45° FOV, color fundus image
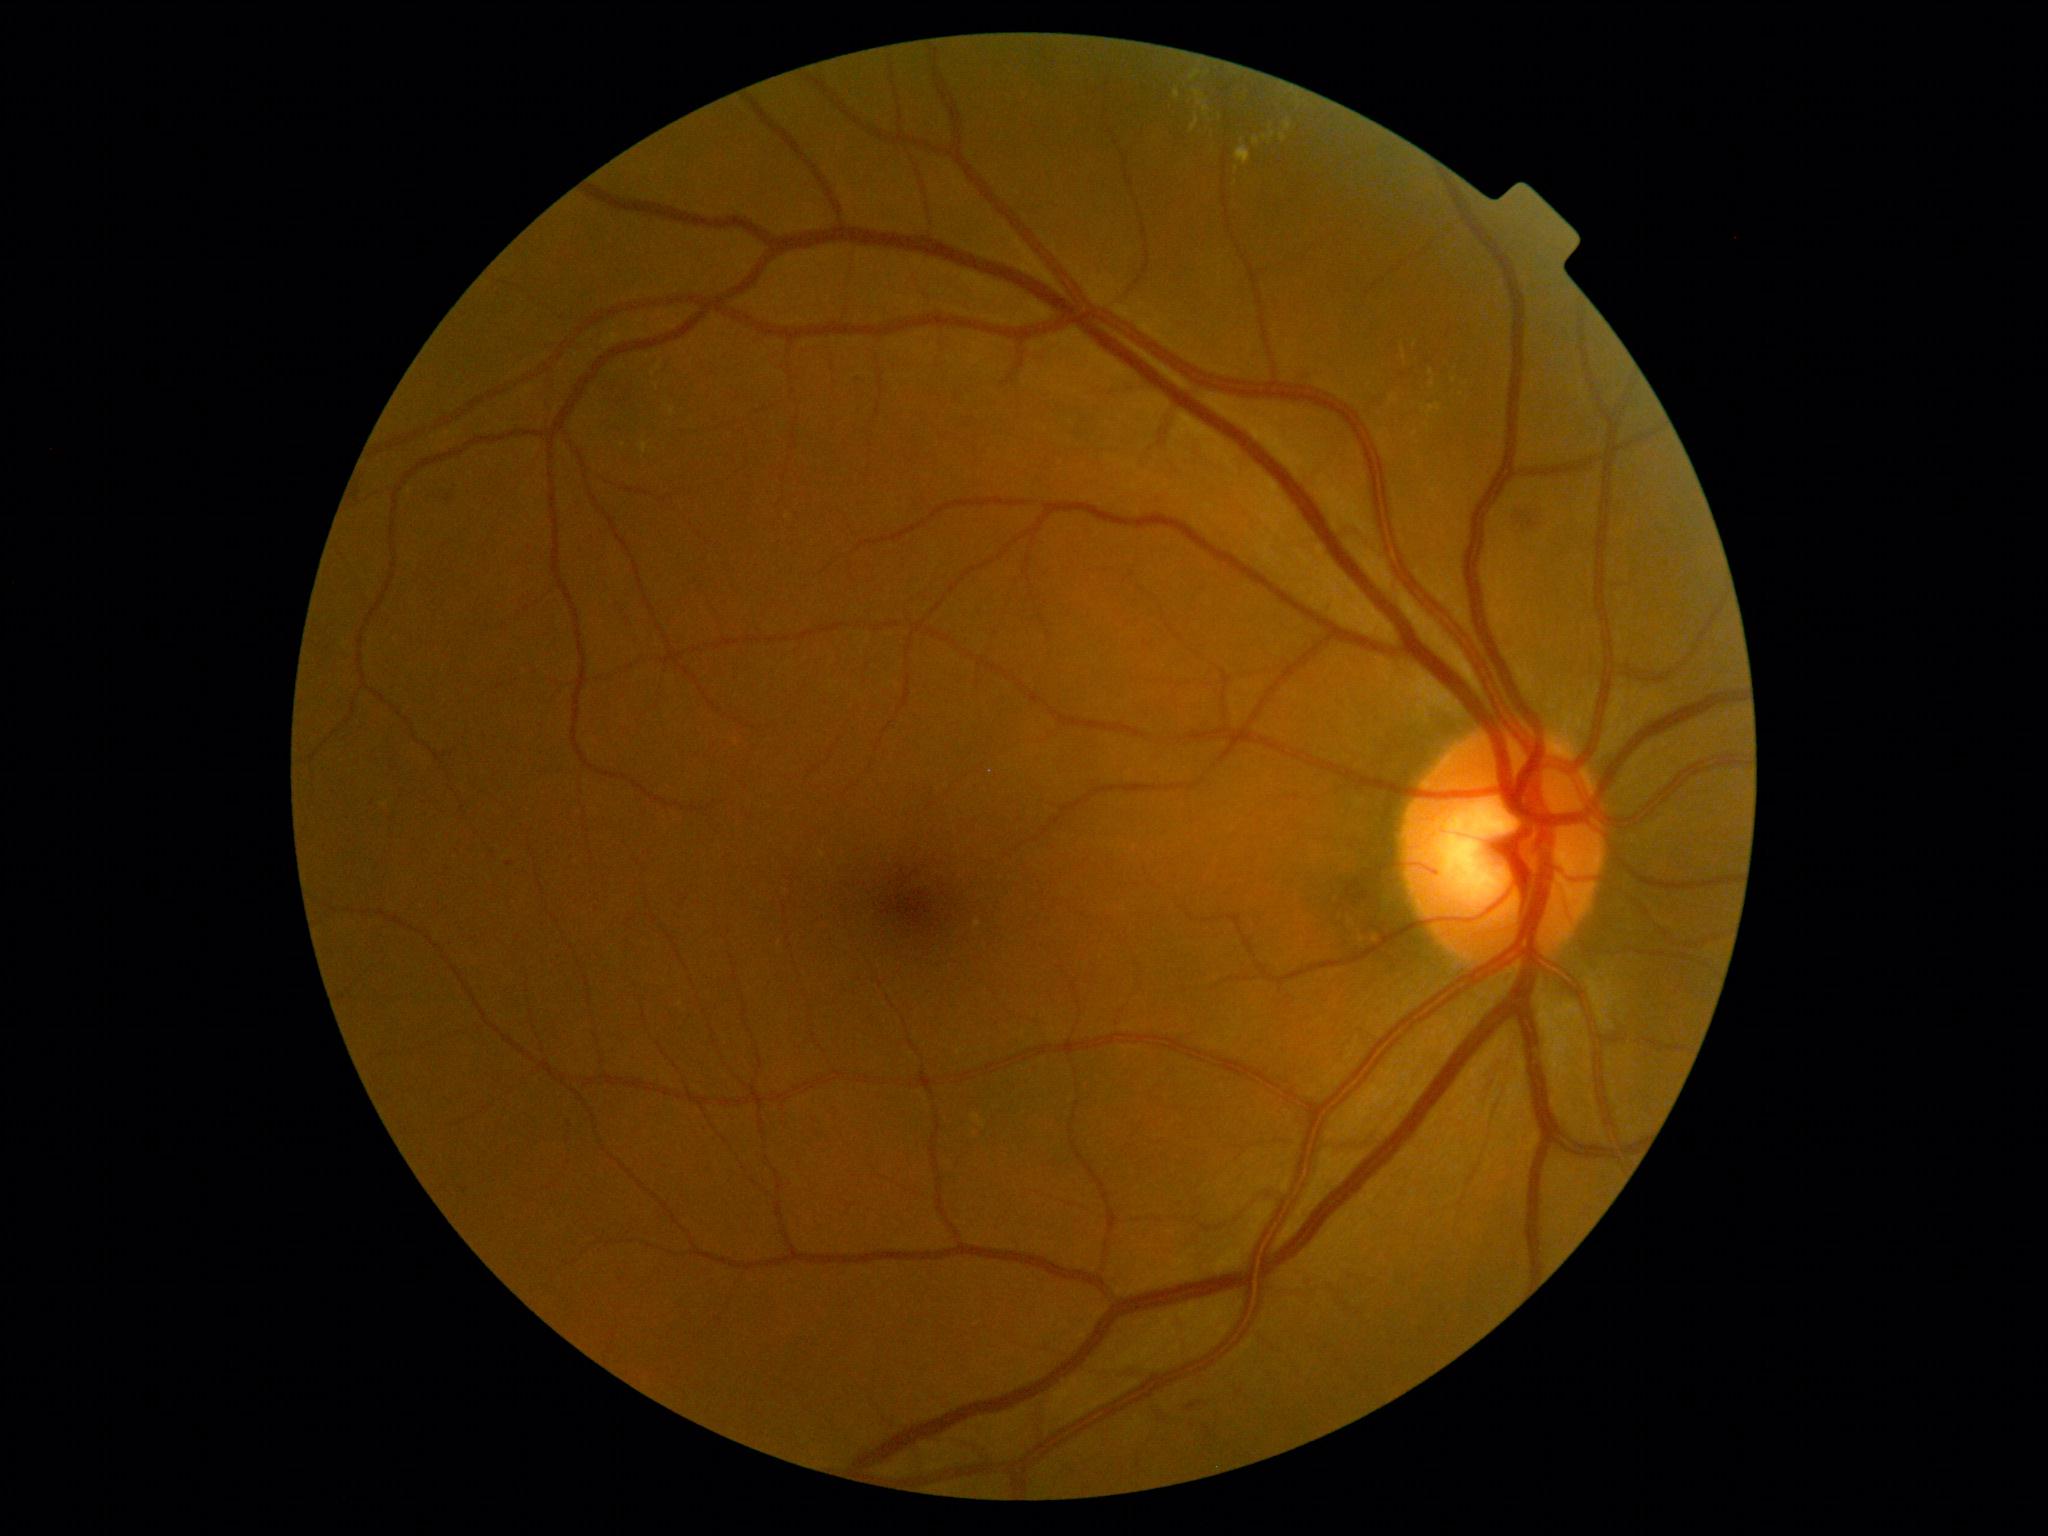 Retinopathy is grade 2 (moderate NPDR).